Image size 2228x1652 · retinal fundus photograph · field includes the optic disc and macula · acquired with a Topcon TRC-50DX.
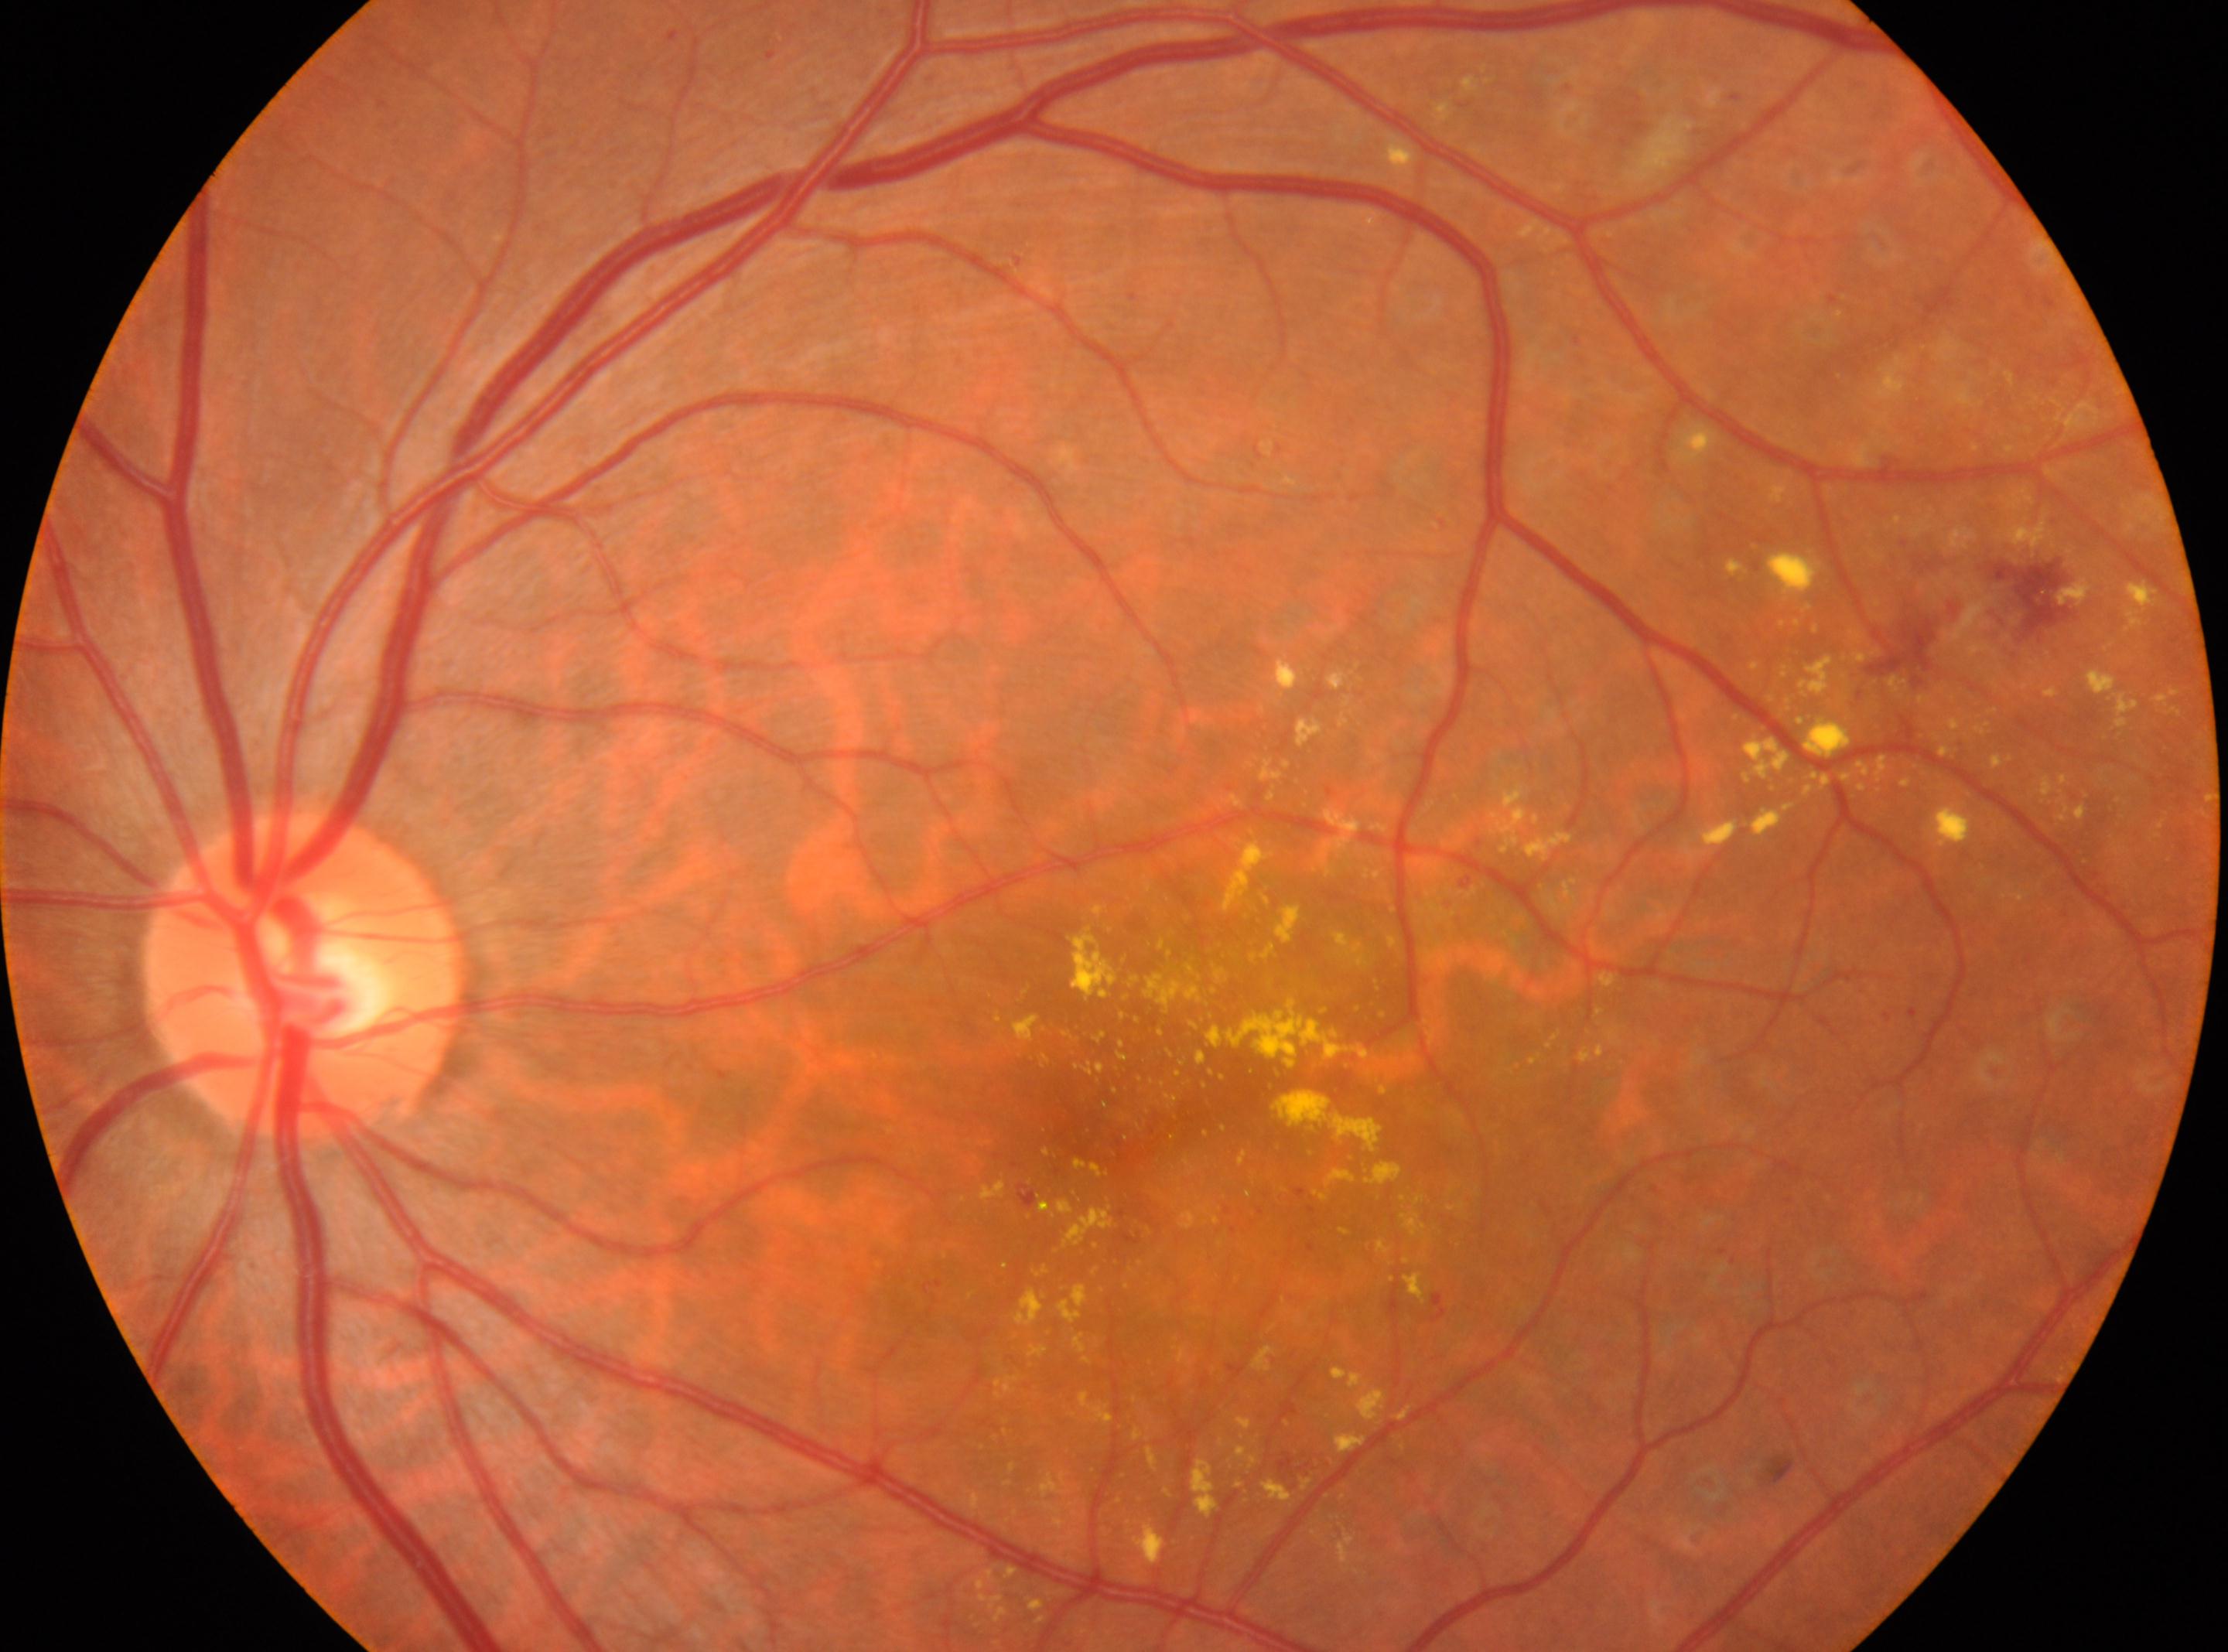

Eye: oculus sinister.
Optic nerve head located at (x: 302, y: 976).
The fovea is at (x: 1095, y: 1117).
DR stage: post-laser DR.